Fundus photo taken with a portable handheld camera.
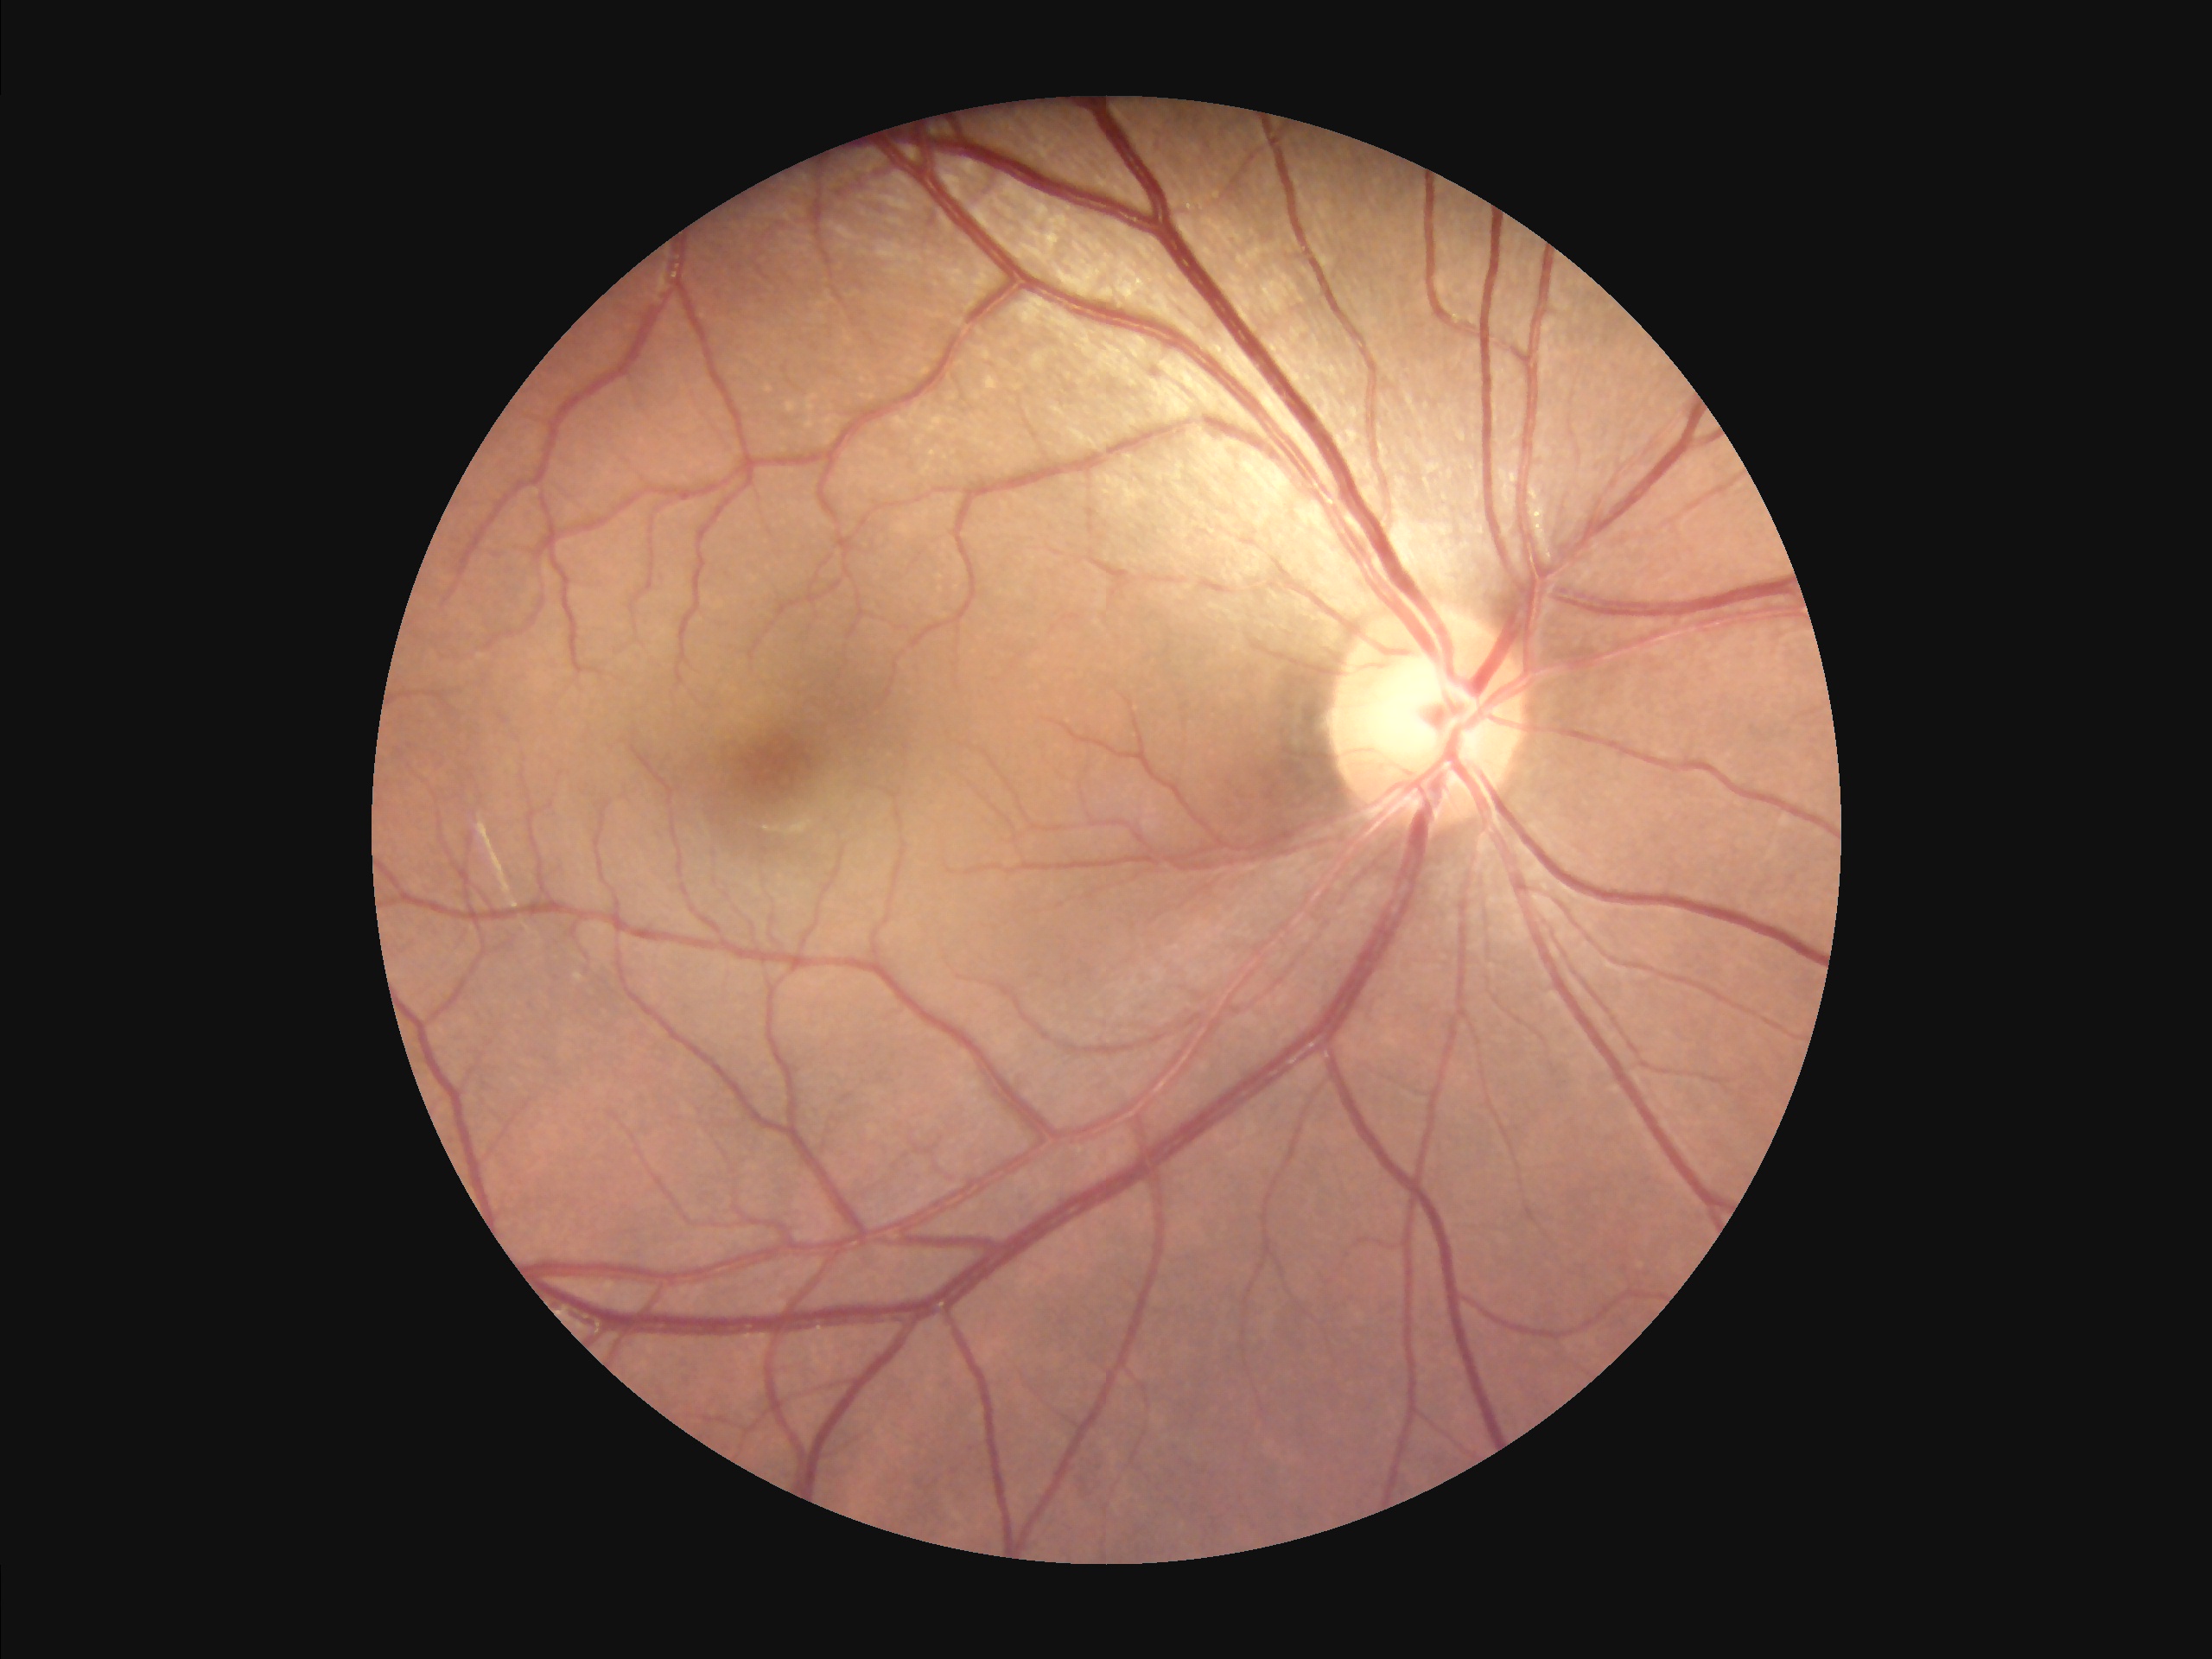
{"illumination": "no over- or under-exposure", "clarity": "sharp throughout the field", "overall_quality": "adequate for clinical interpretation"}